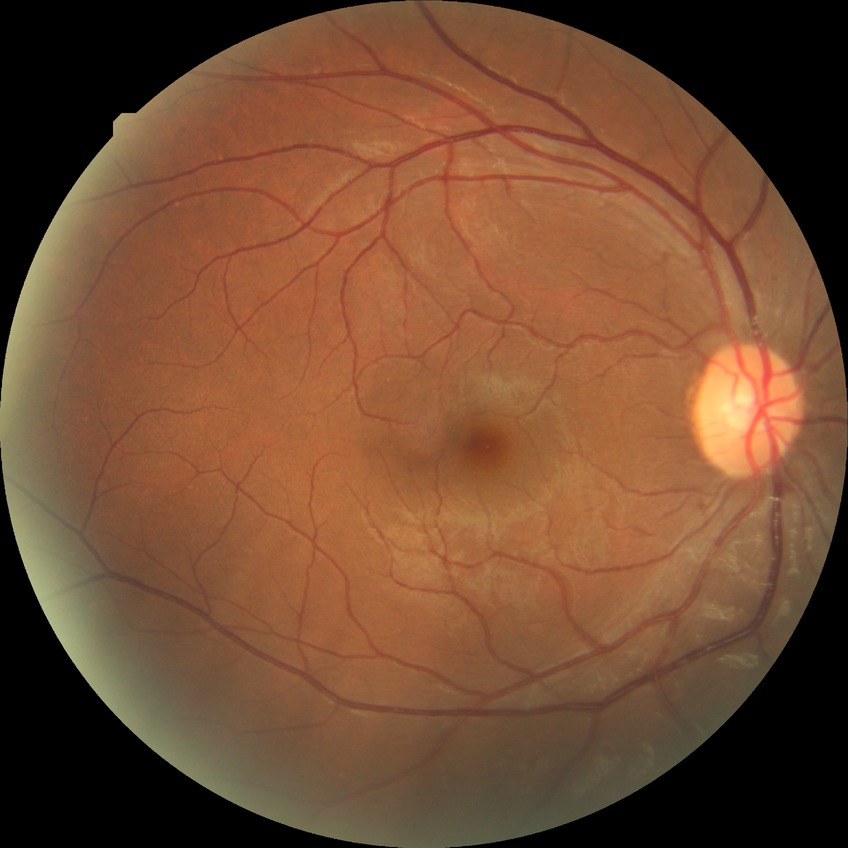
Modified Davis classification: no diabetic retinopathy.